Image size 1440x1080 · wide-field fundus photograph of an infant:
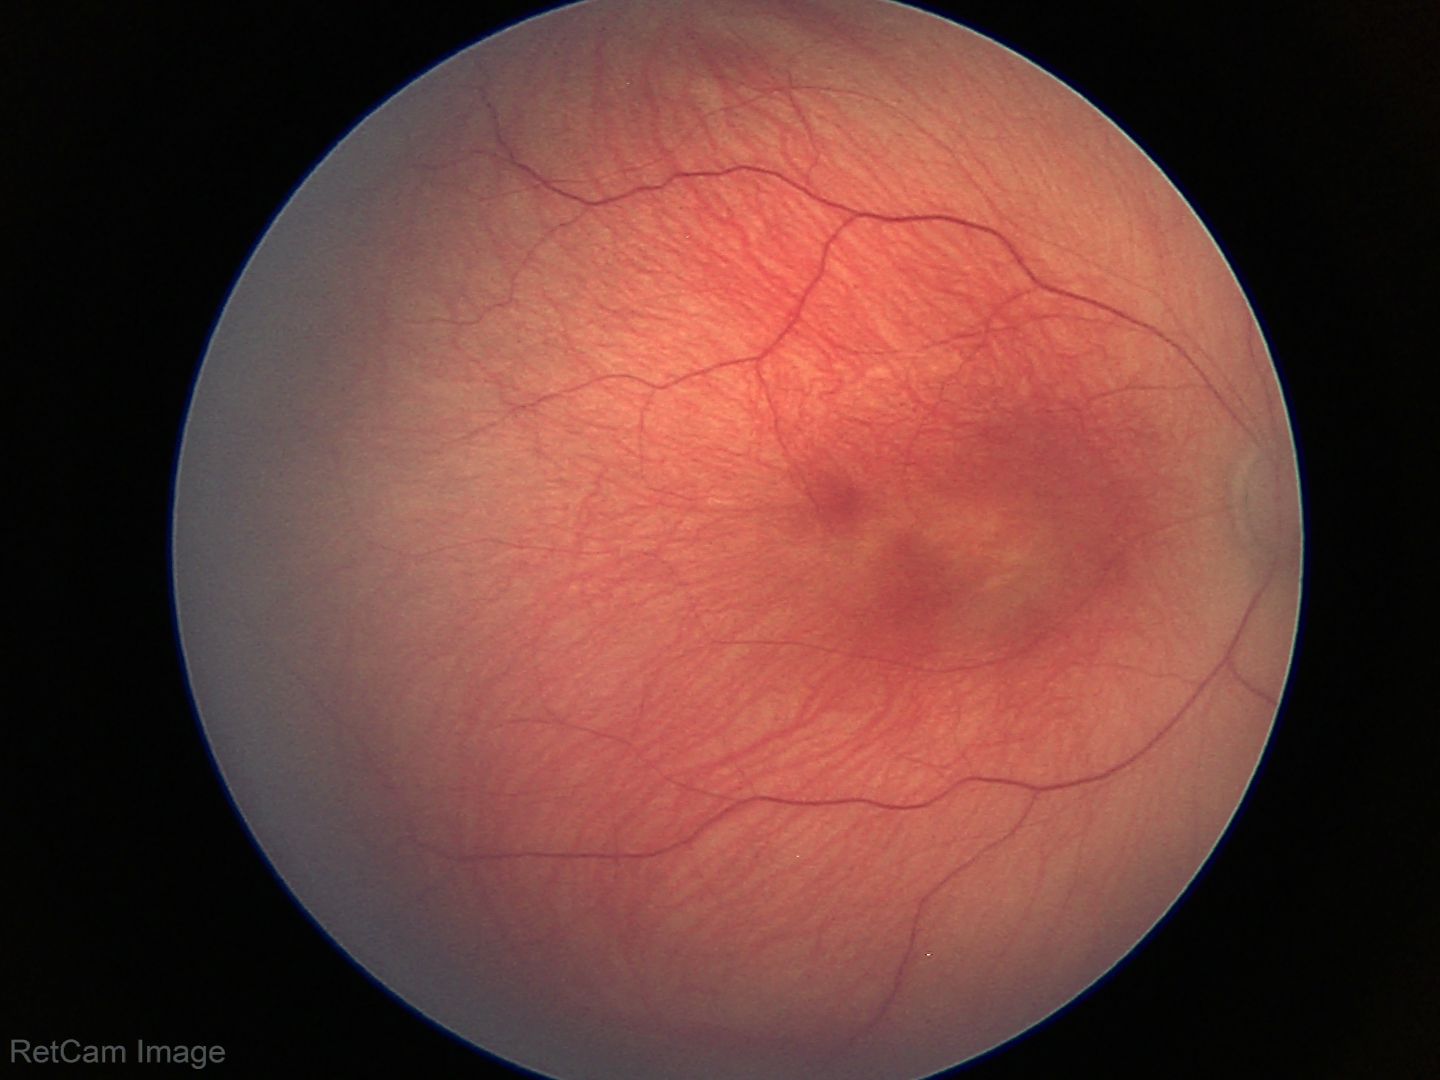 Assessment: status post retinopathy of prematurity — retinal appearance after treated retinopathy of prematurity
plus form: absent